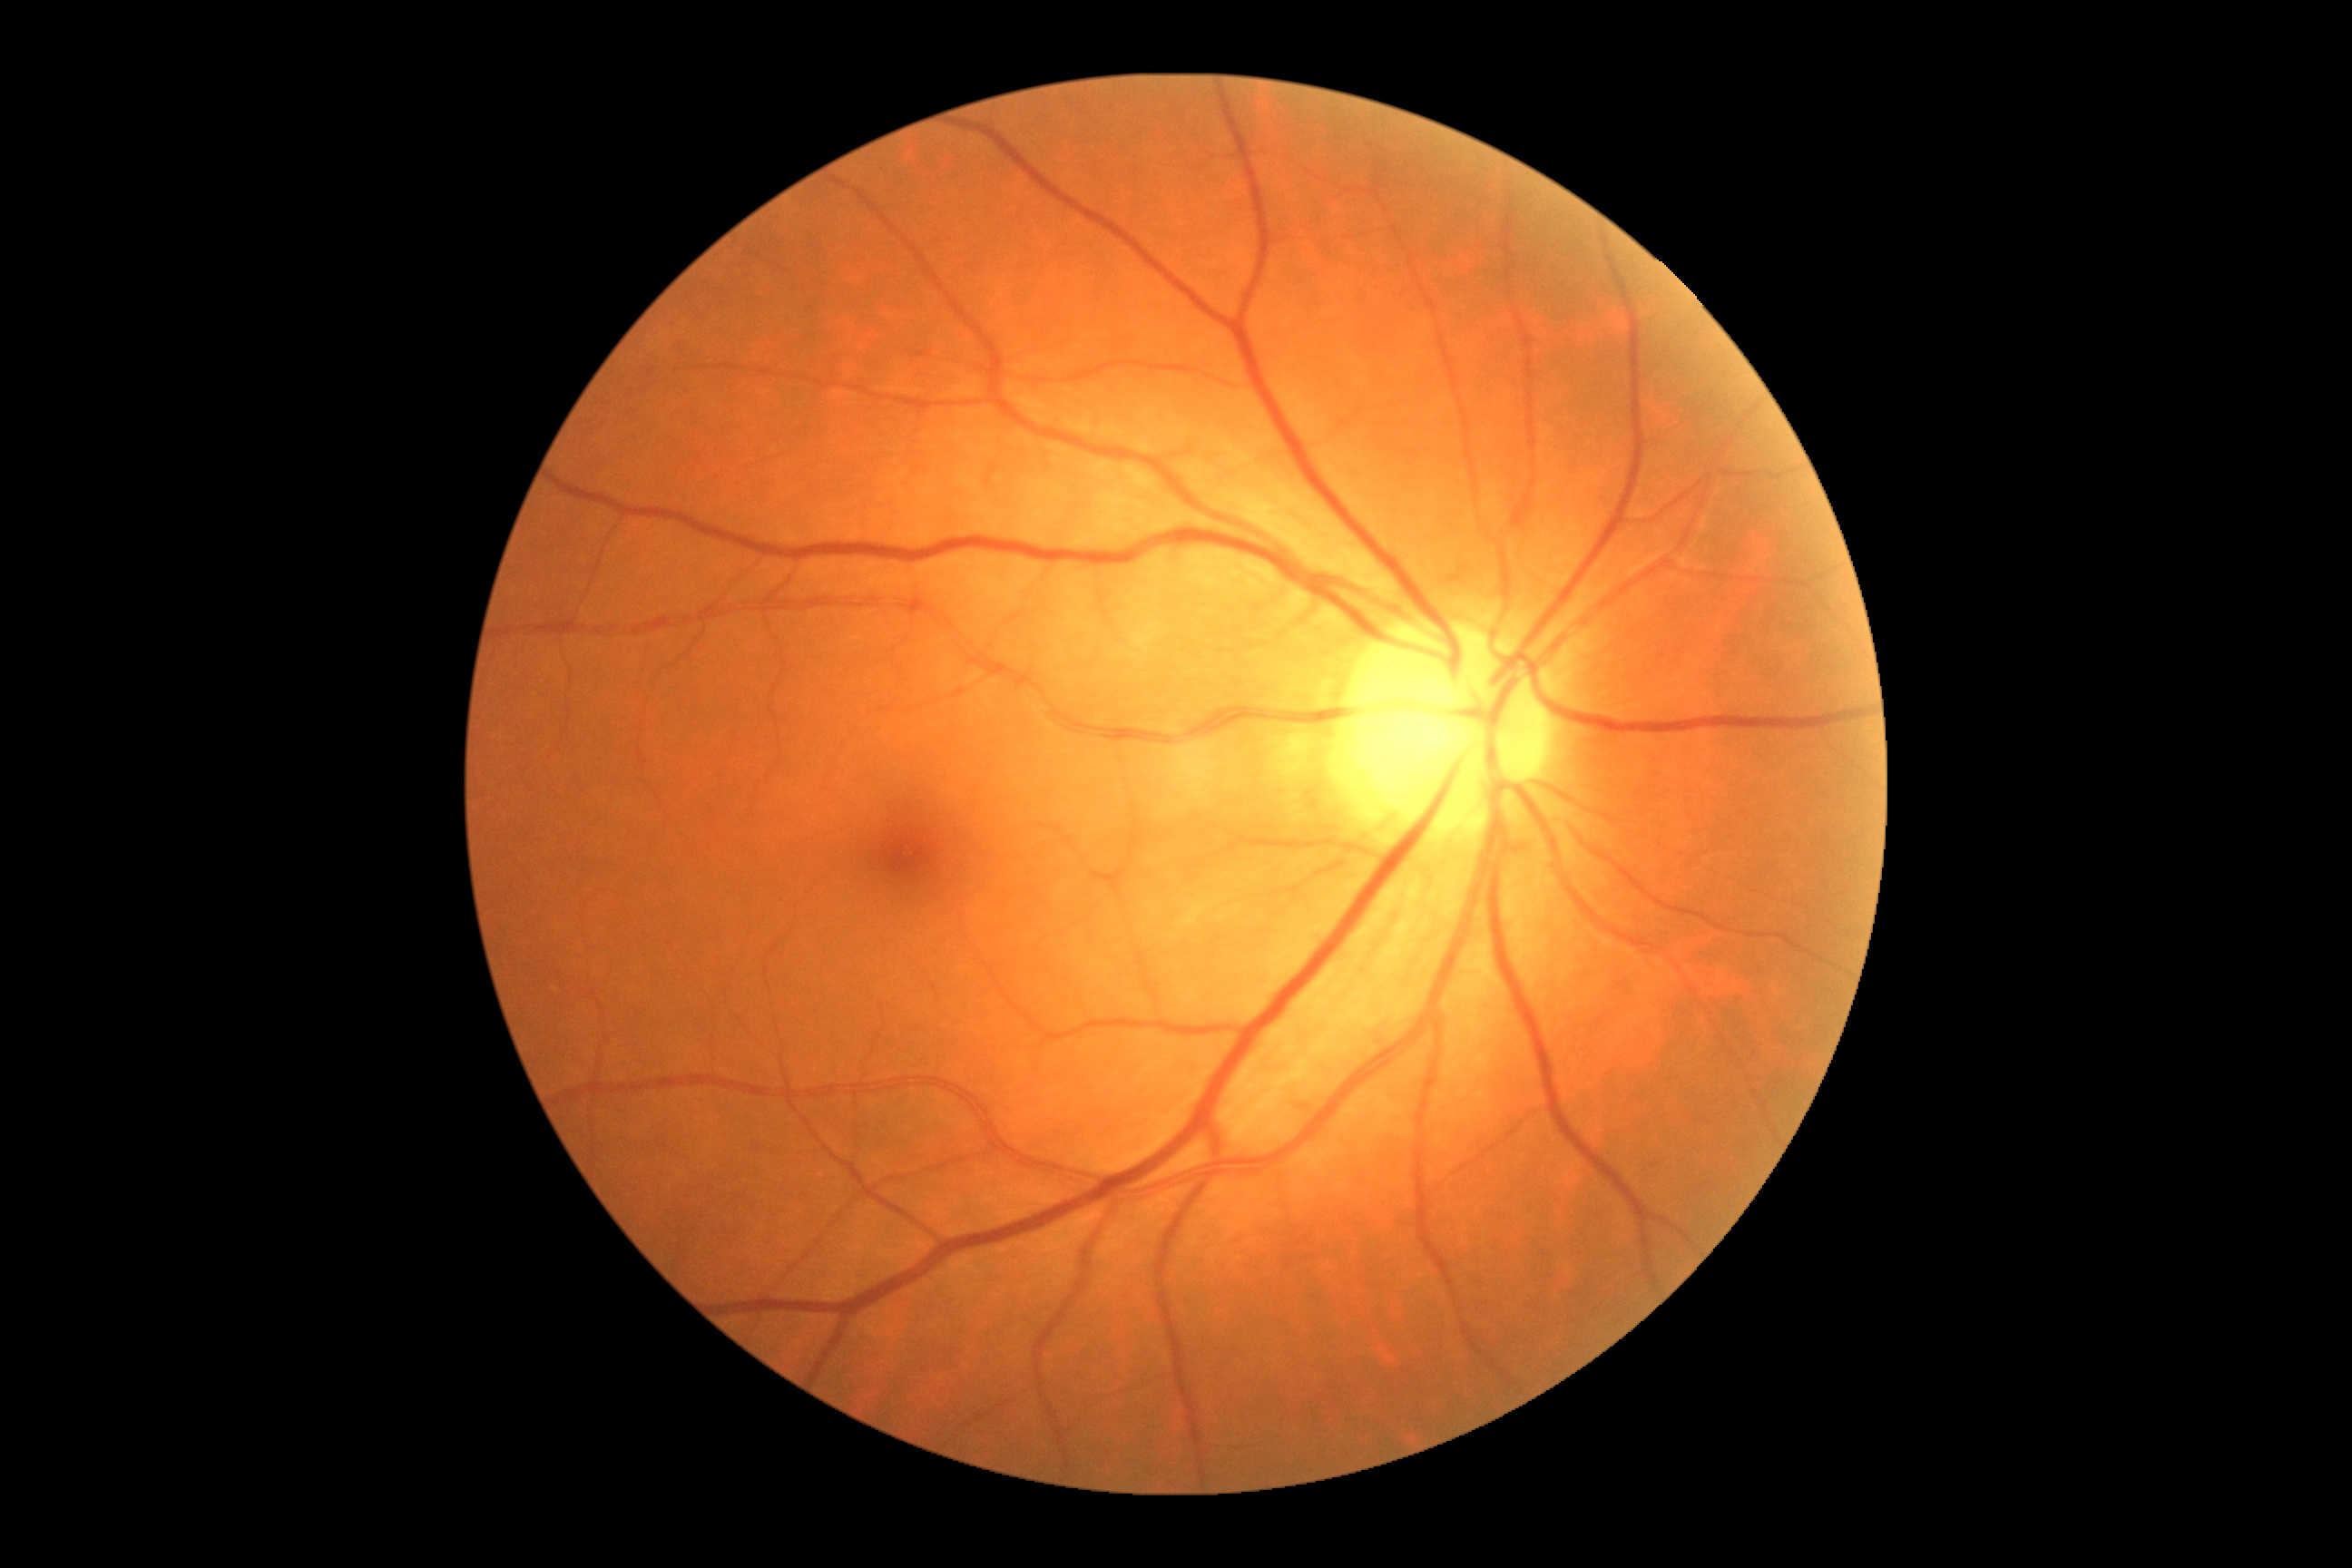

Retinopathy: no apparent retinopathy (grade 0) — no visible signs of diabetic retinopathy.